Fundus photo, 2352x1568, 45° FOV — 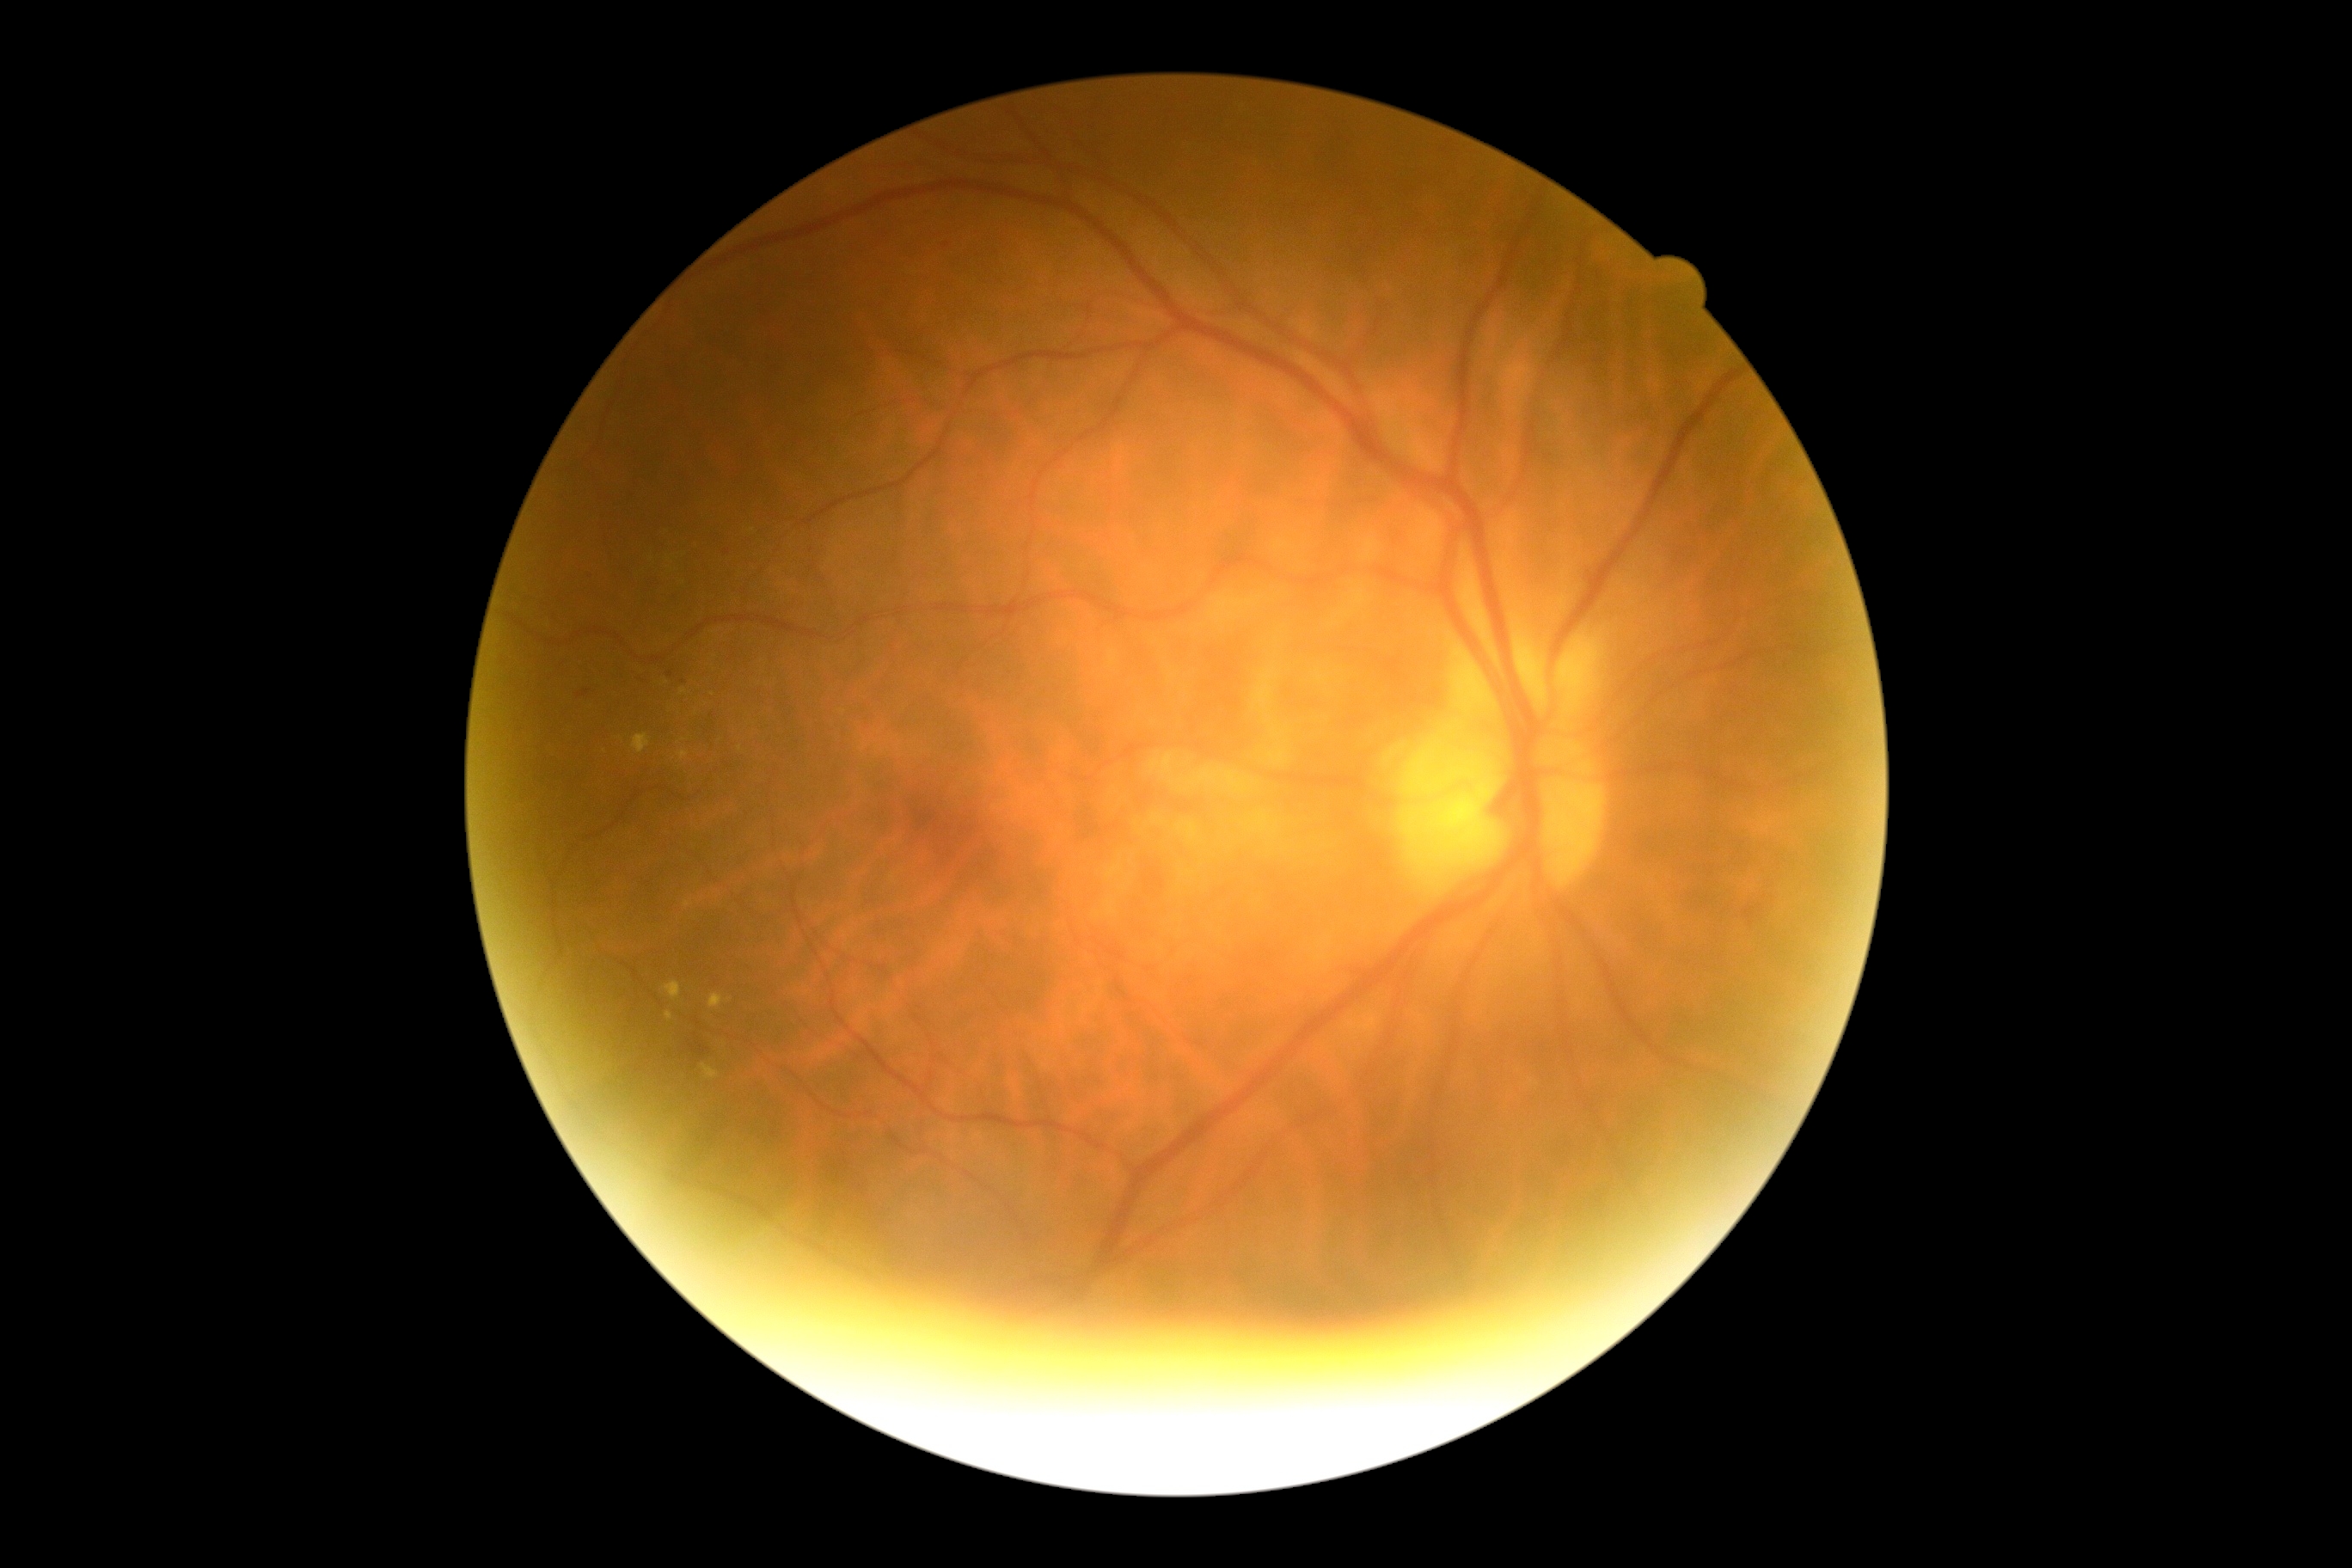 Diabetic retinopathy grade is moderate non-proliferative diabetic retinopathy (2). DR class: non-proliferative diabetic retinopathy.